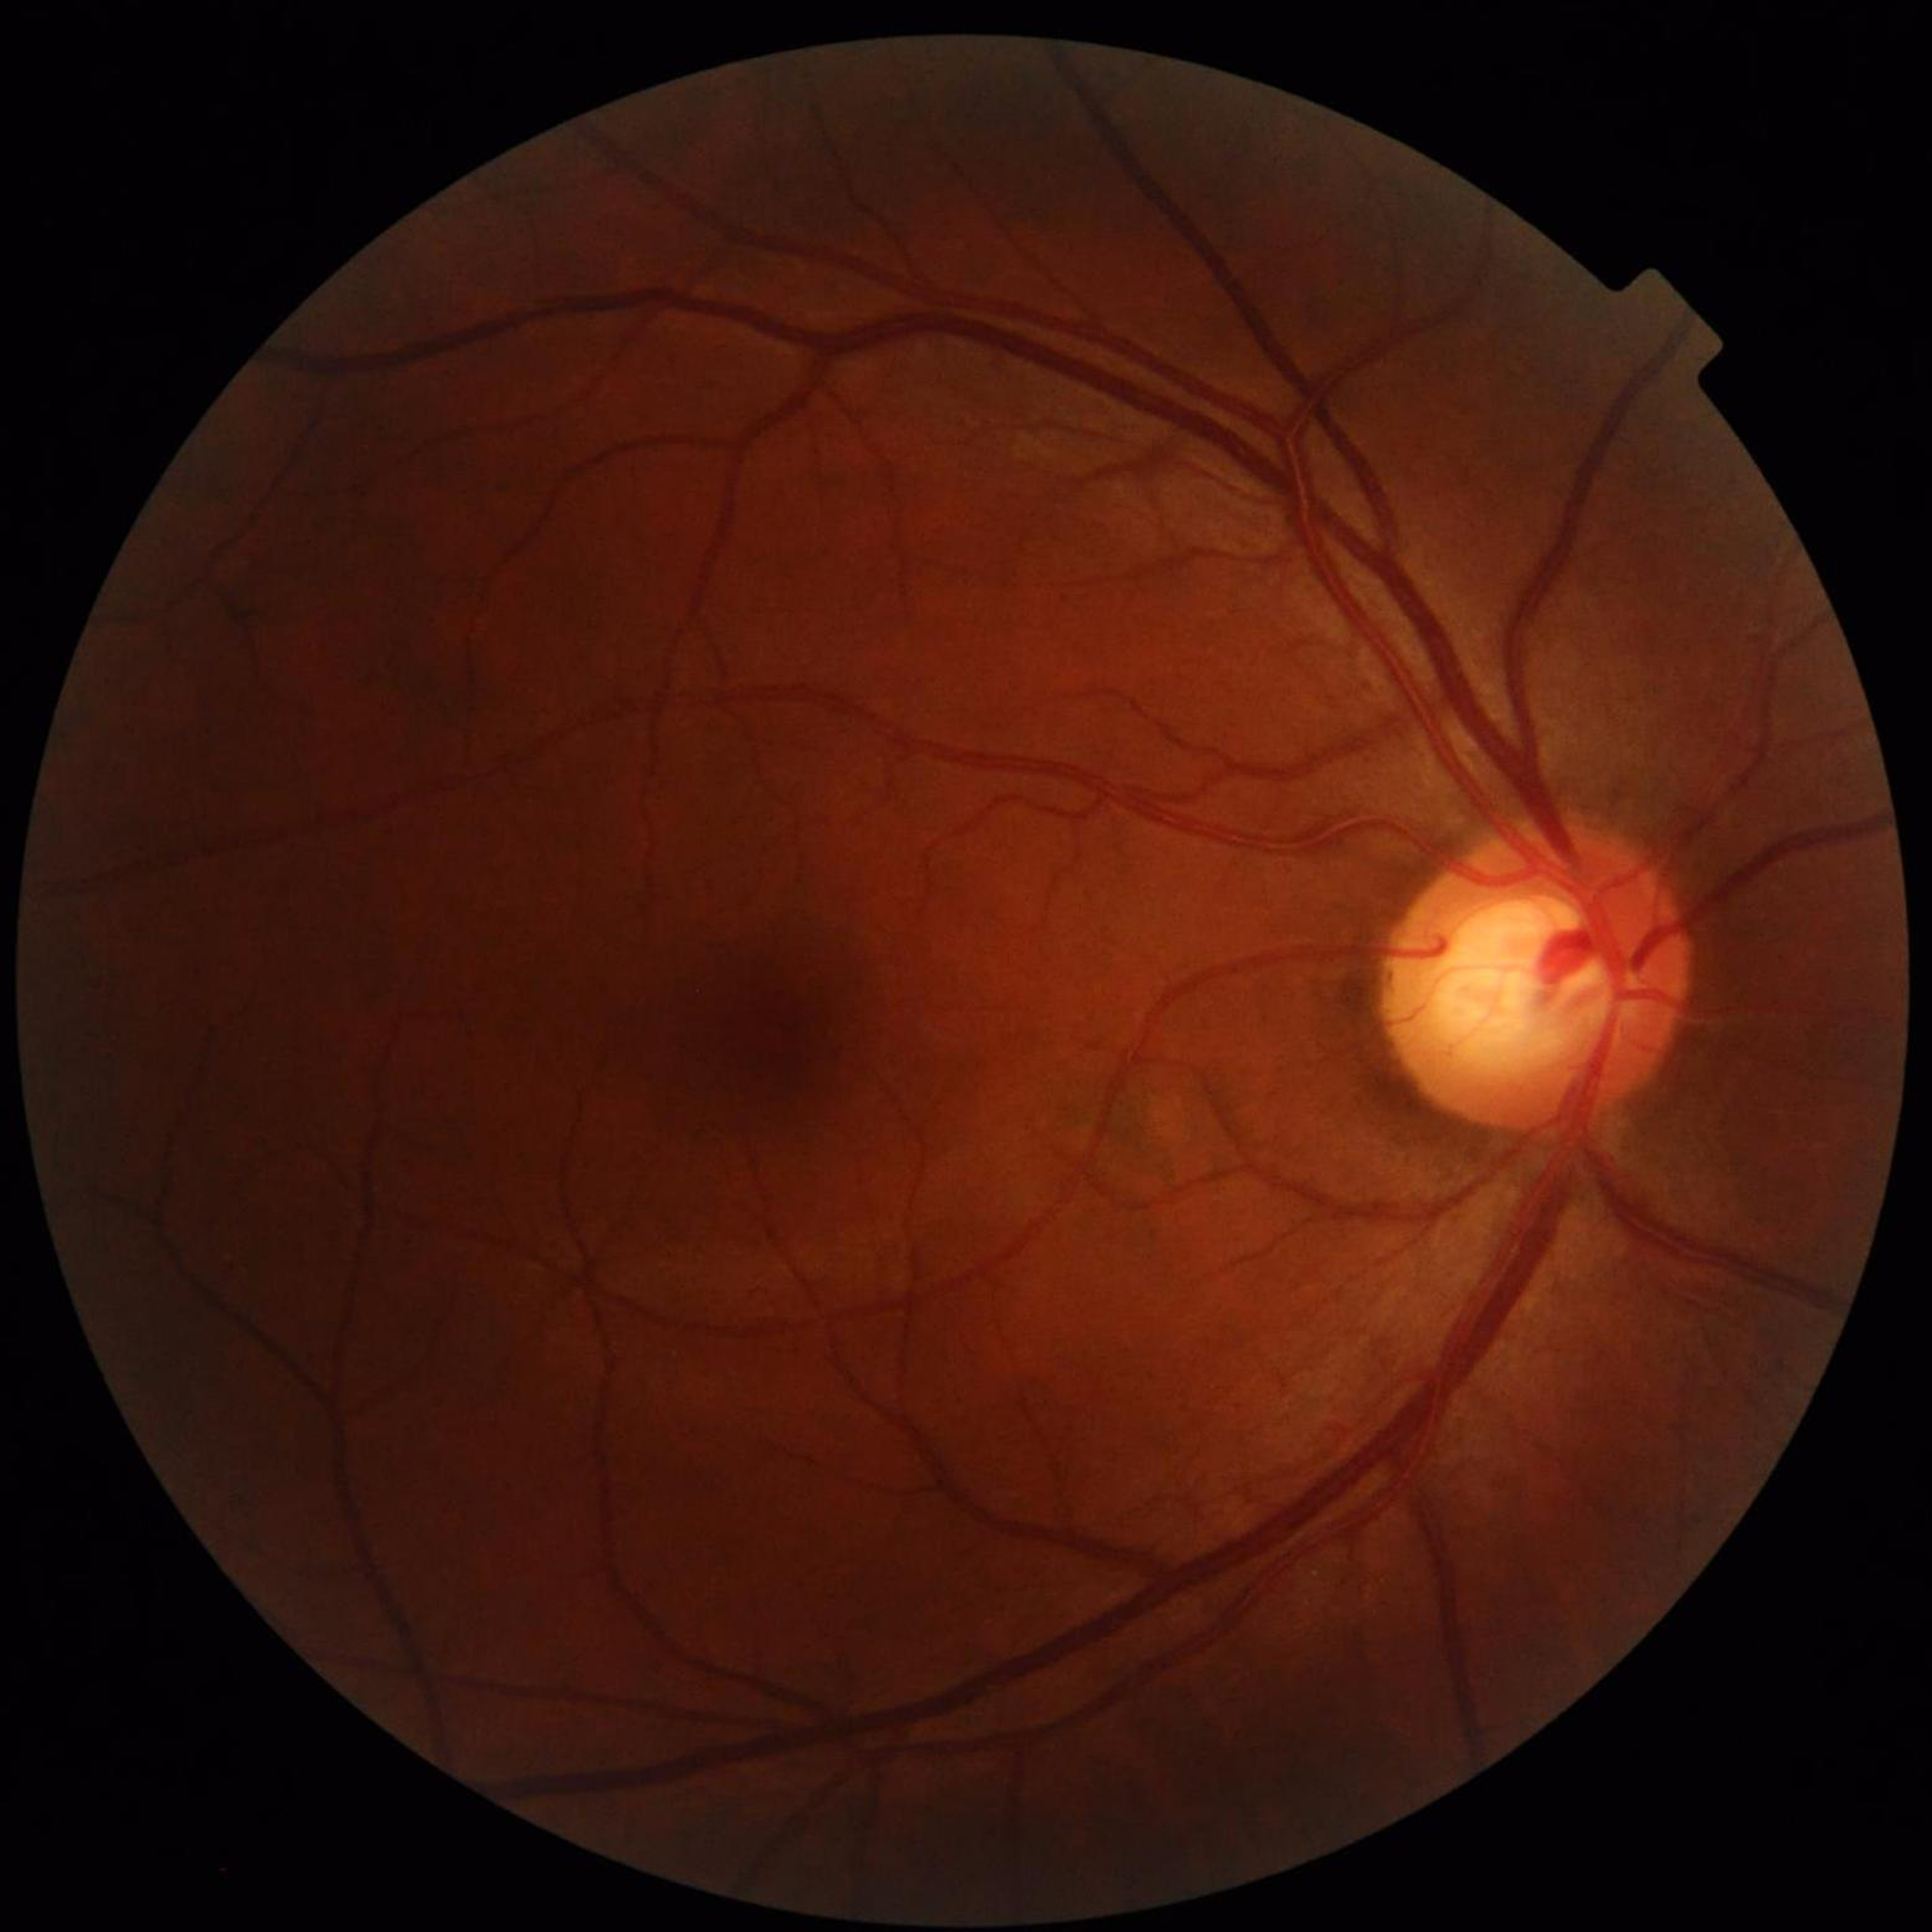 Impression: glaucoma.